Modified Davis classification: 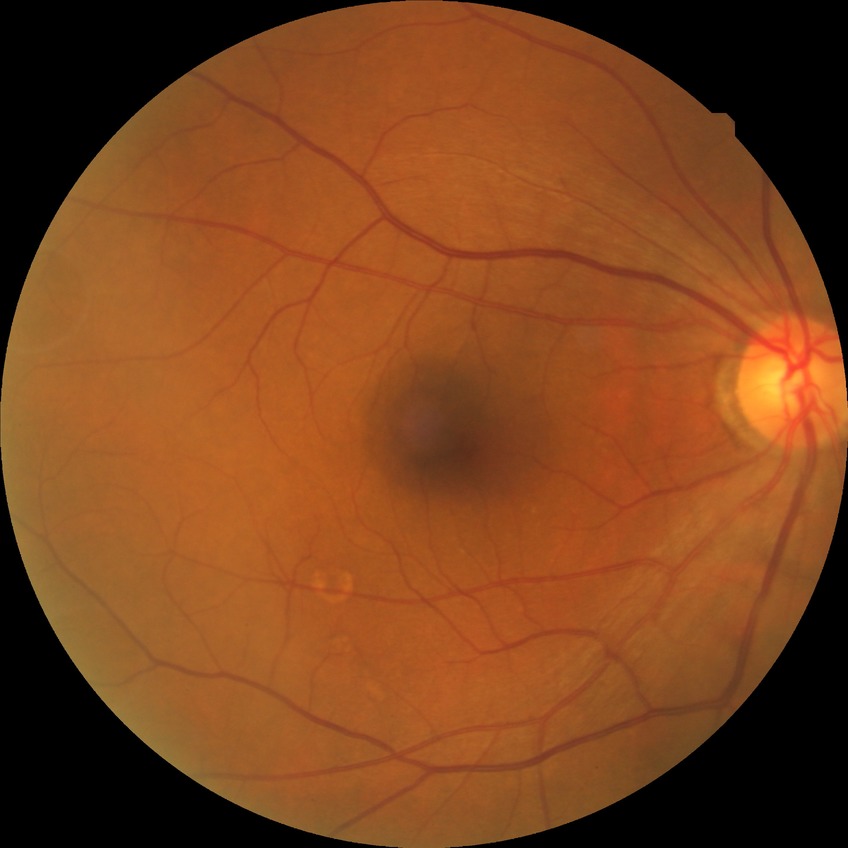

Diabetic retinopathy (DR): no diabetic retinopathy (NDR).